Wide-field fundus photograph of an infant · 1240 by 1240 pixels — 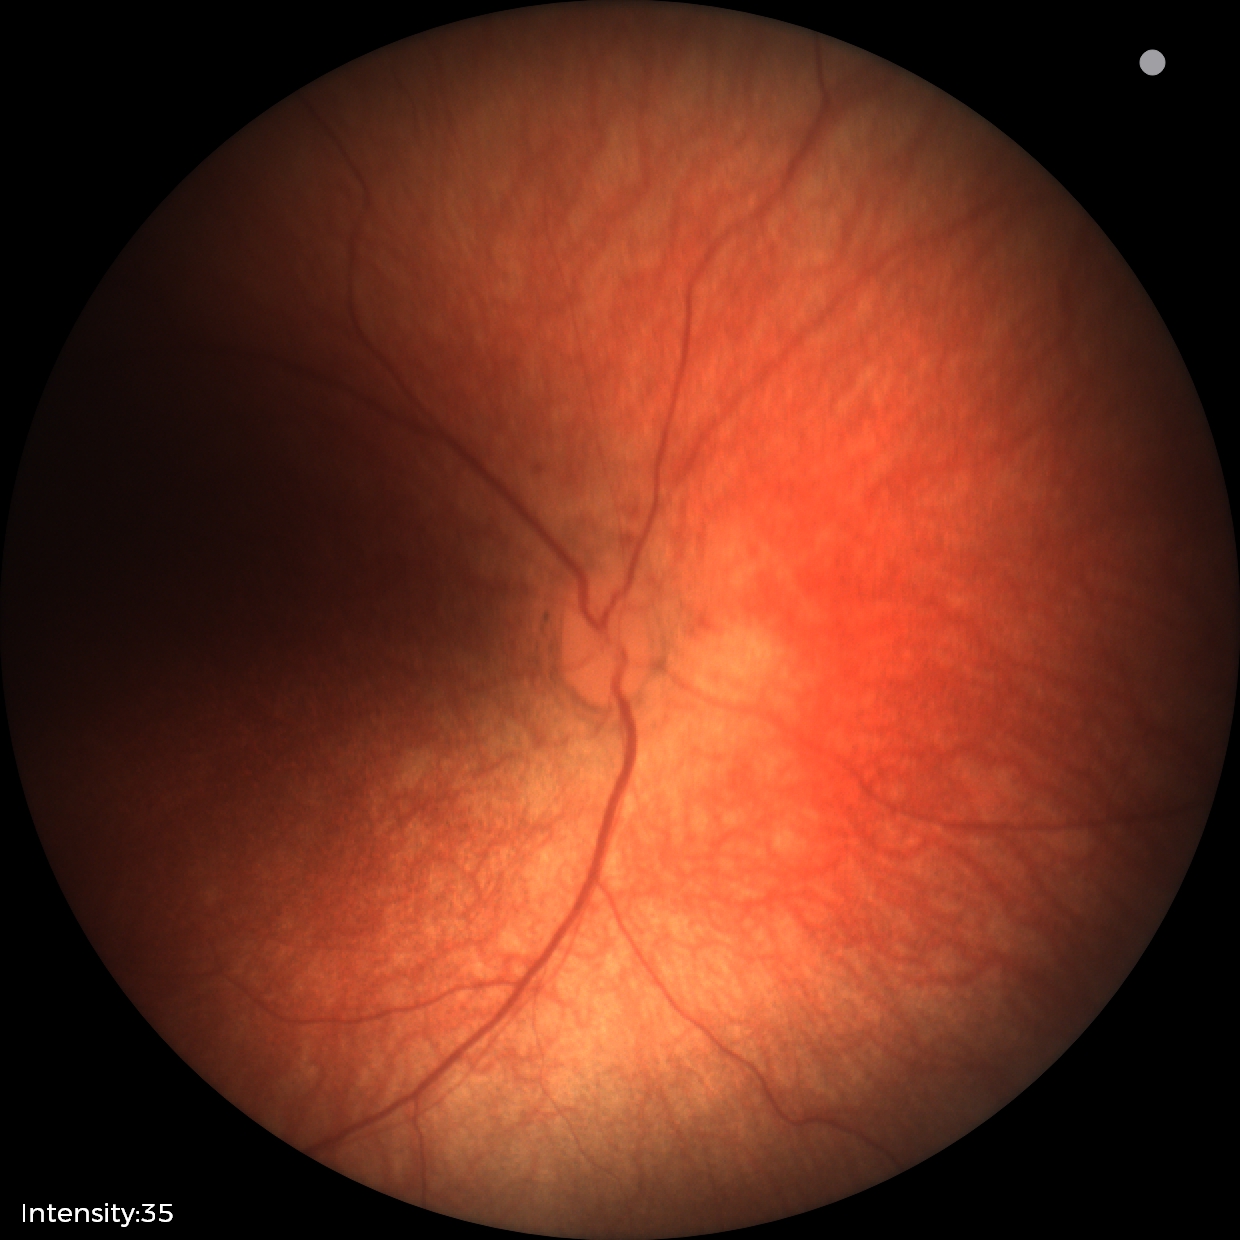

Q: What is the screening diagnosis?
A: normal retinal appearance